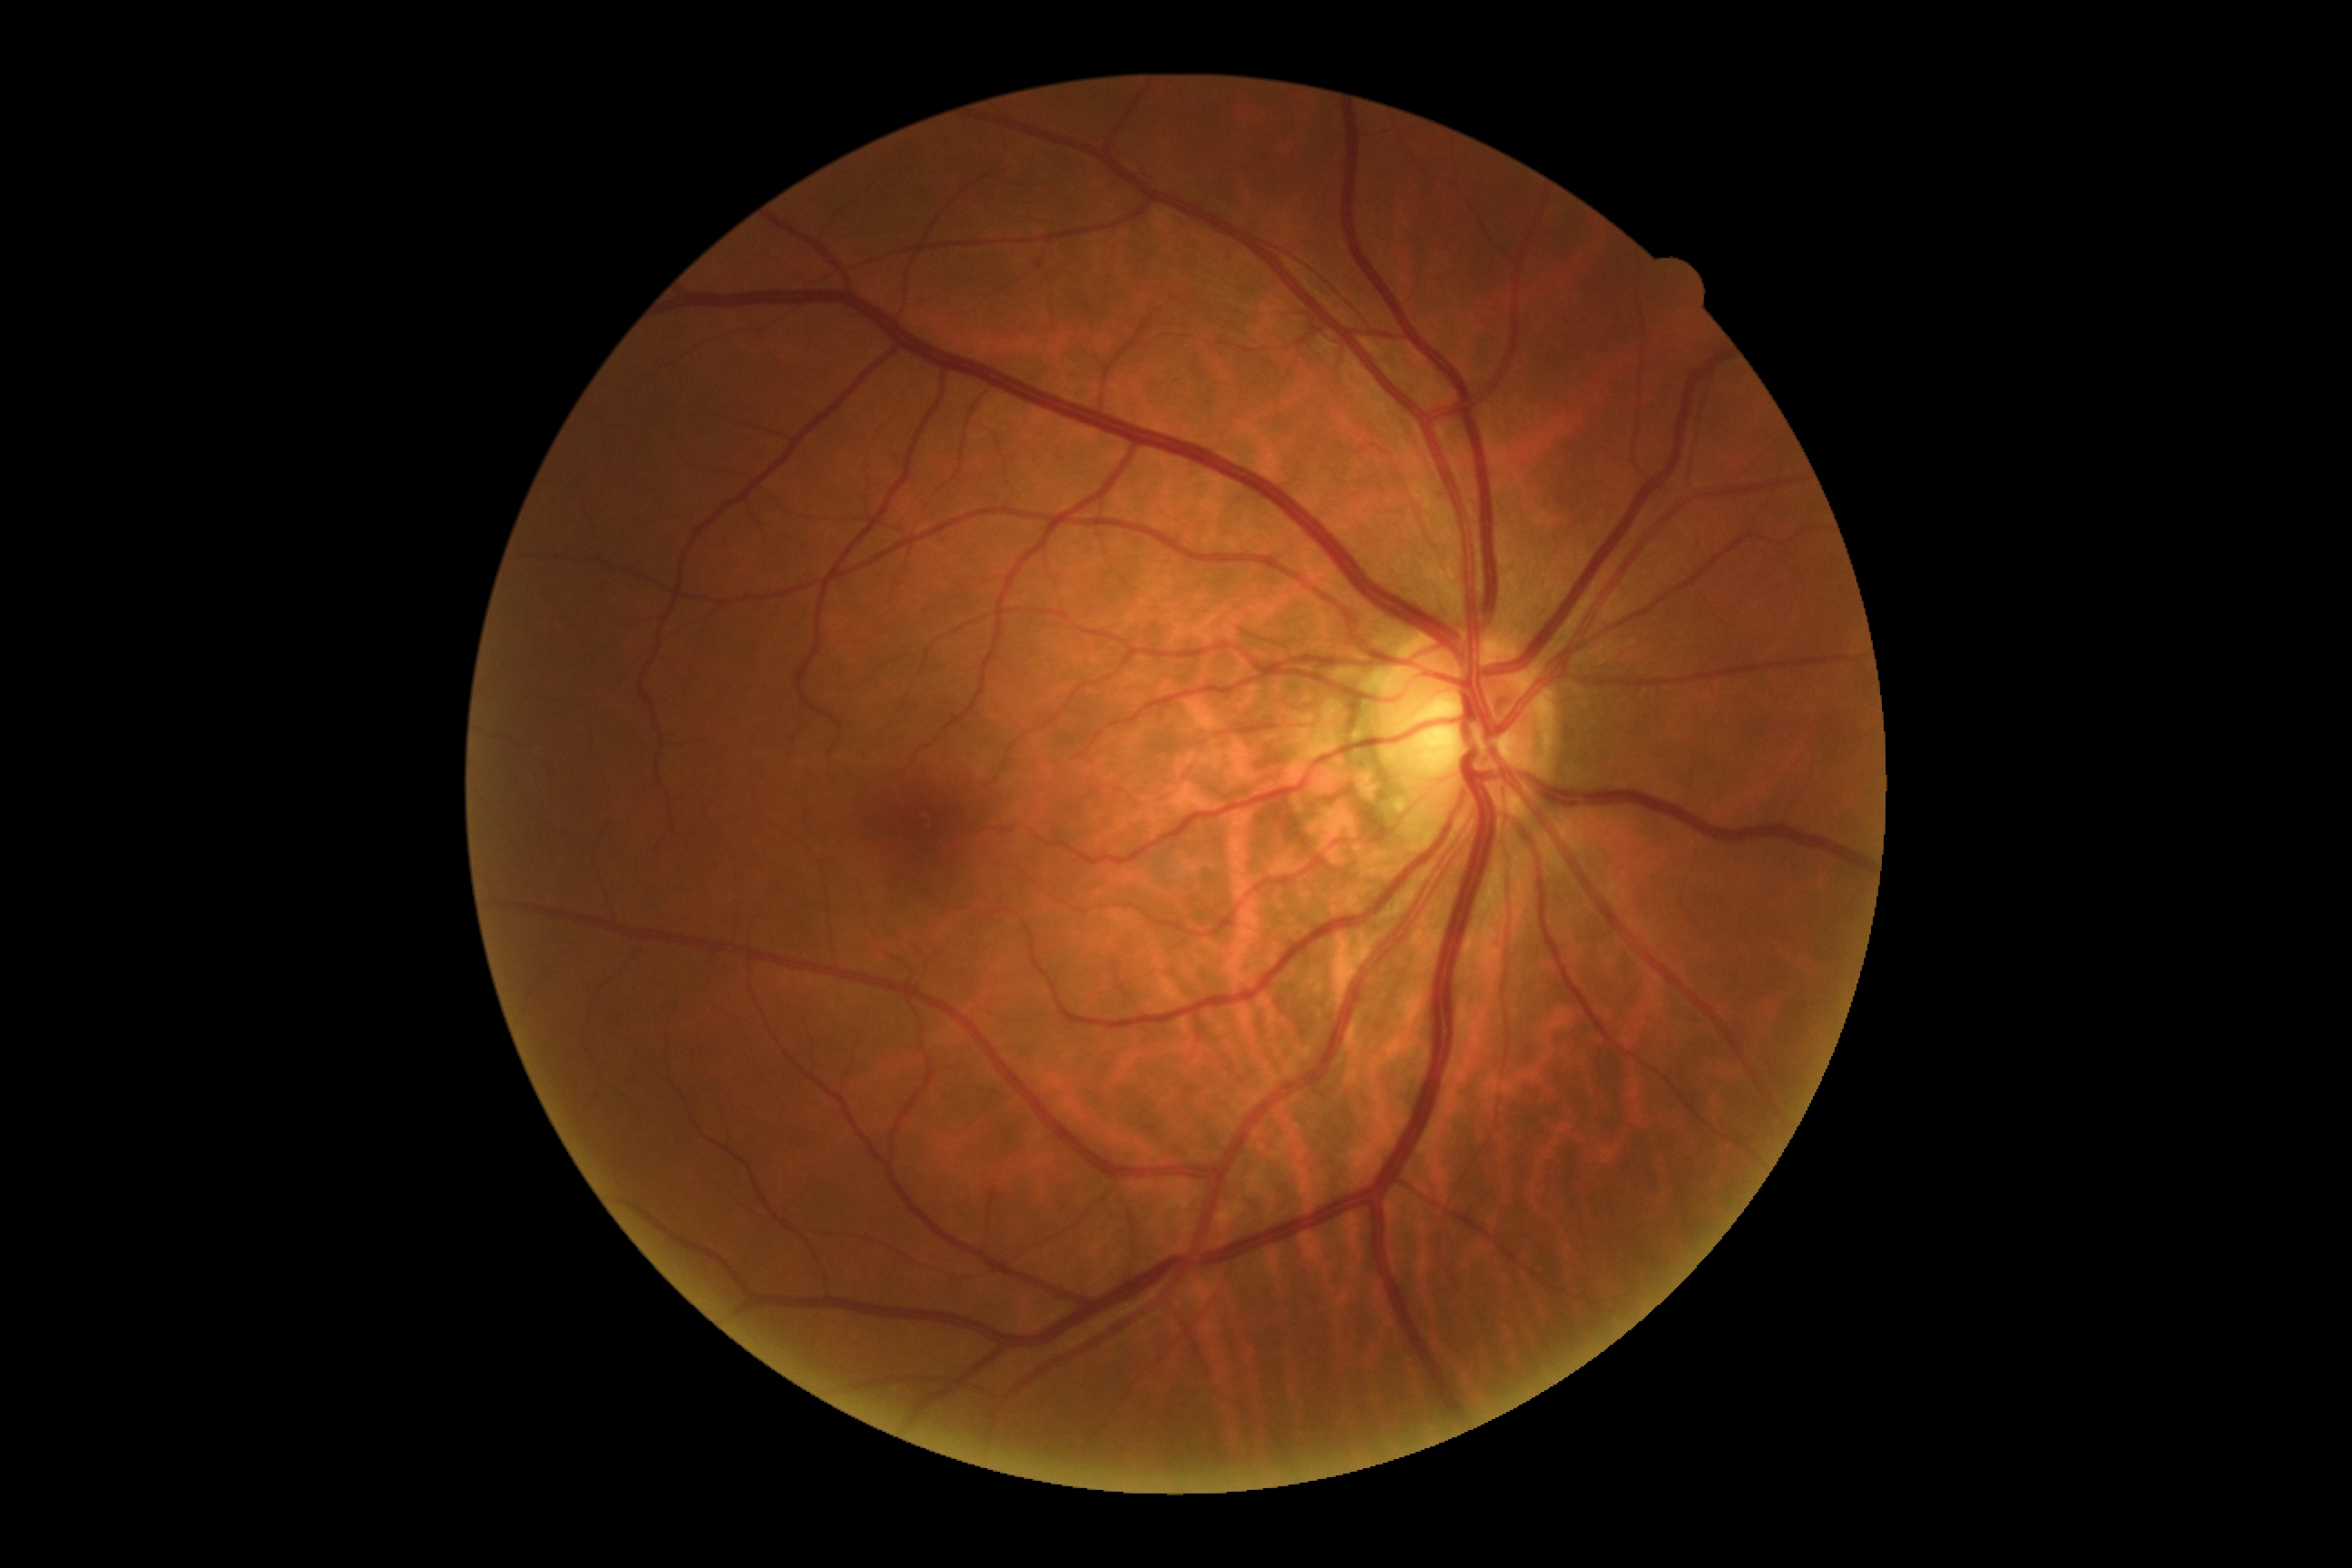
Diabetic retinopathy is no apparent diabetic retinopathy (grade 0).